Wide-field contact fundus photograph of an infant; Phoenix ICON, 100° FOV: 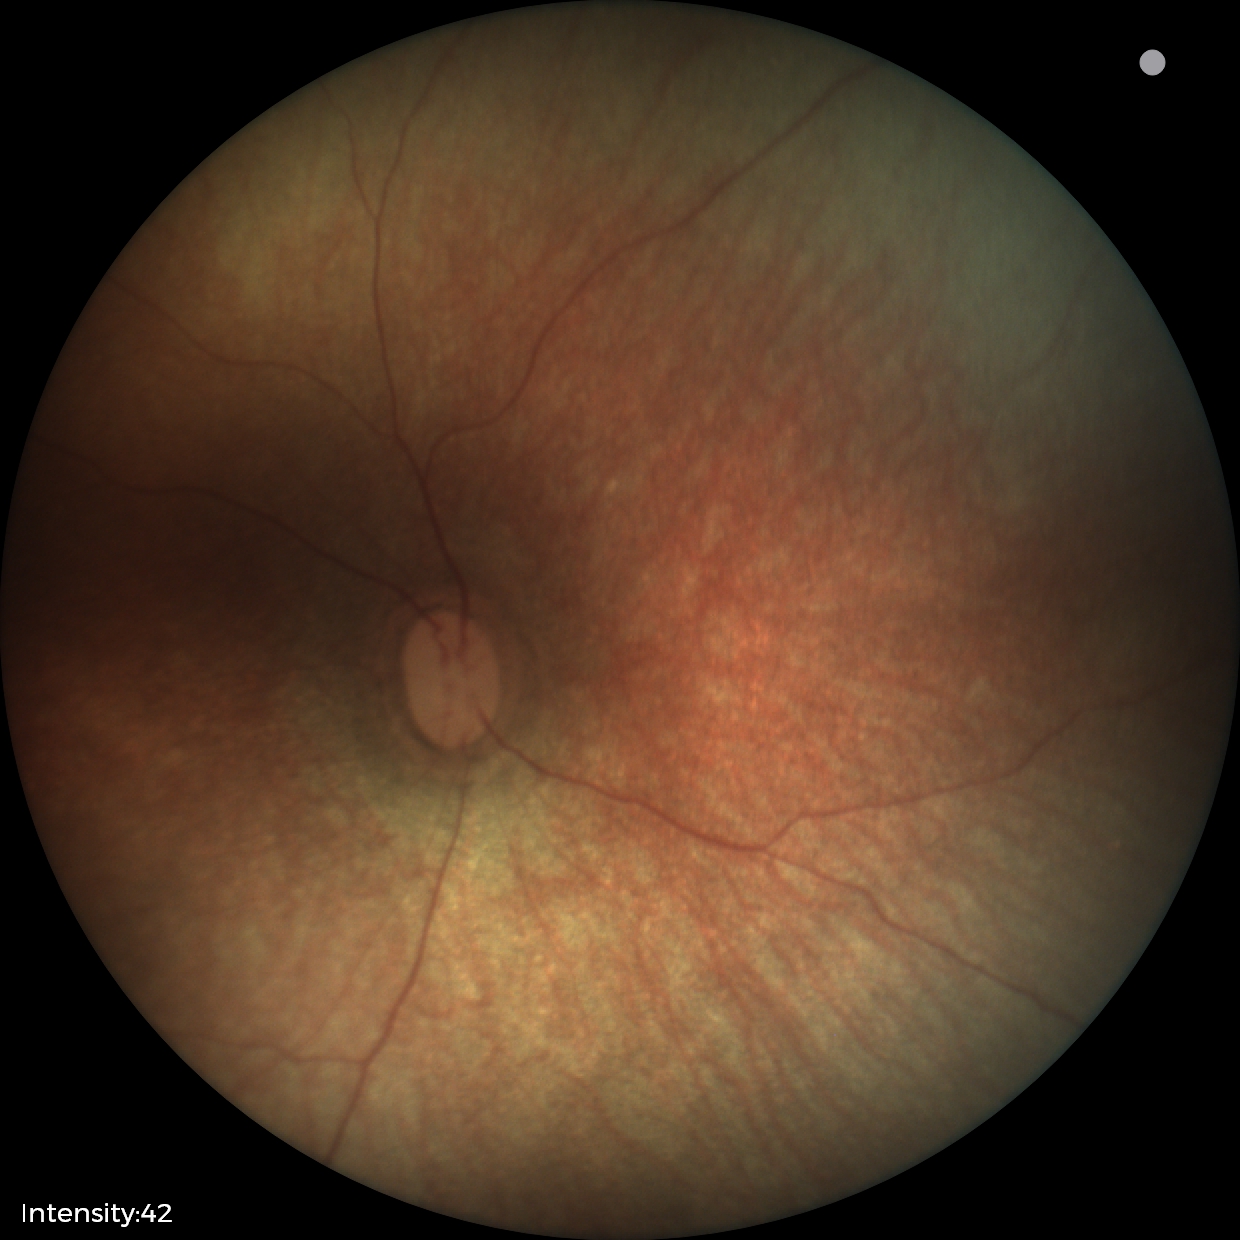
Impression: normal.